2212 by 1672 pixels, 45° FOV:
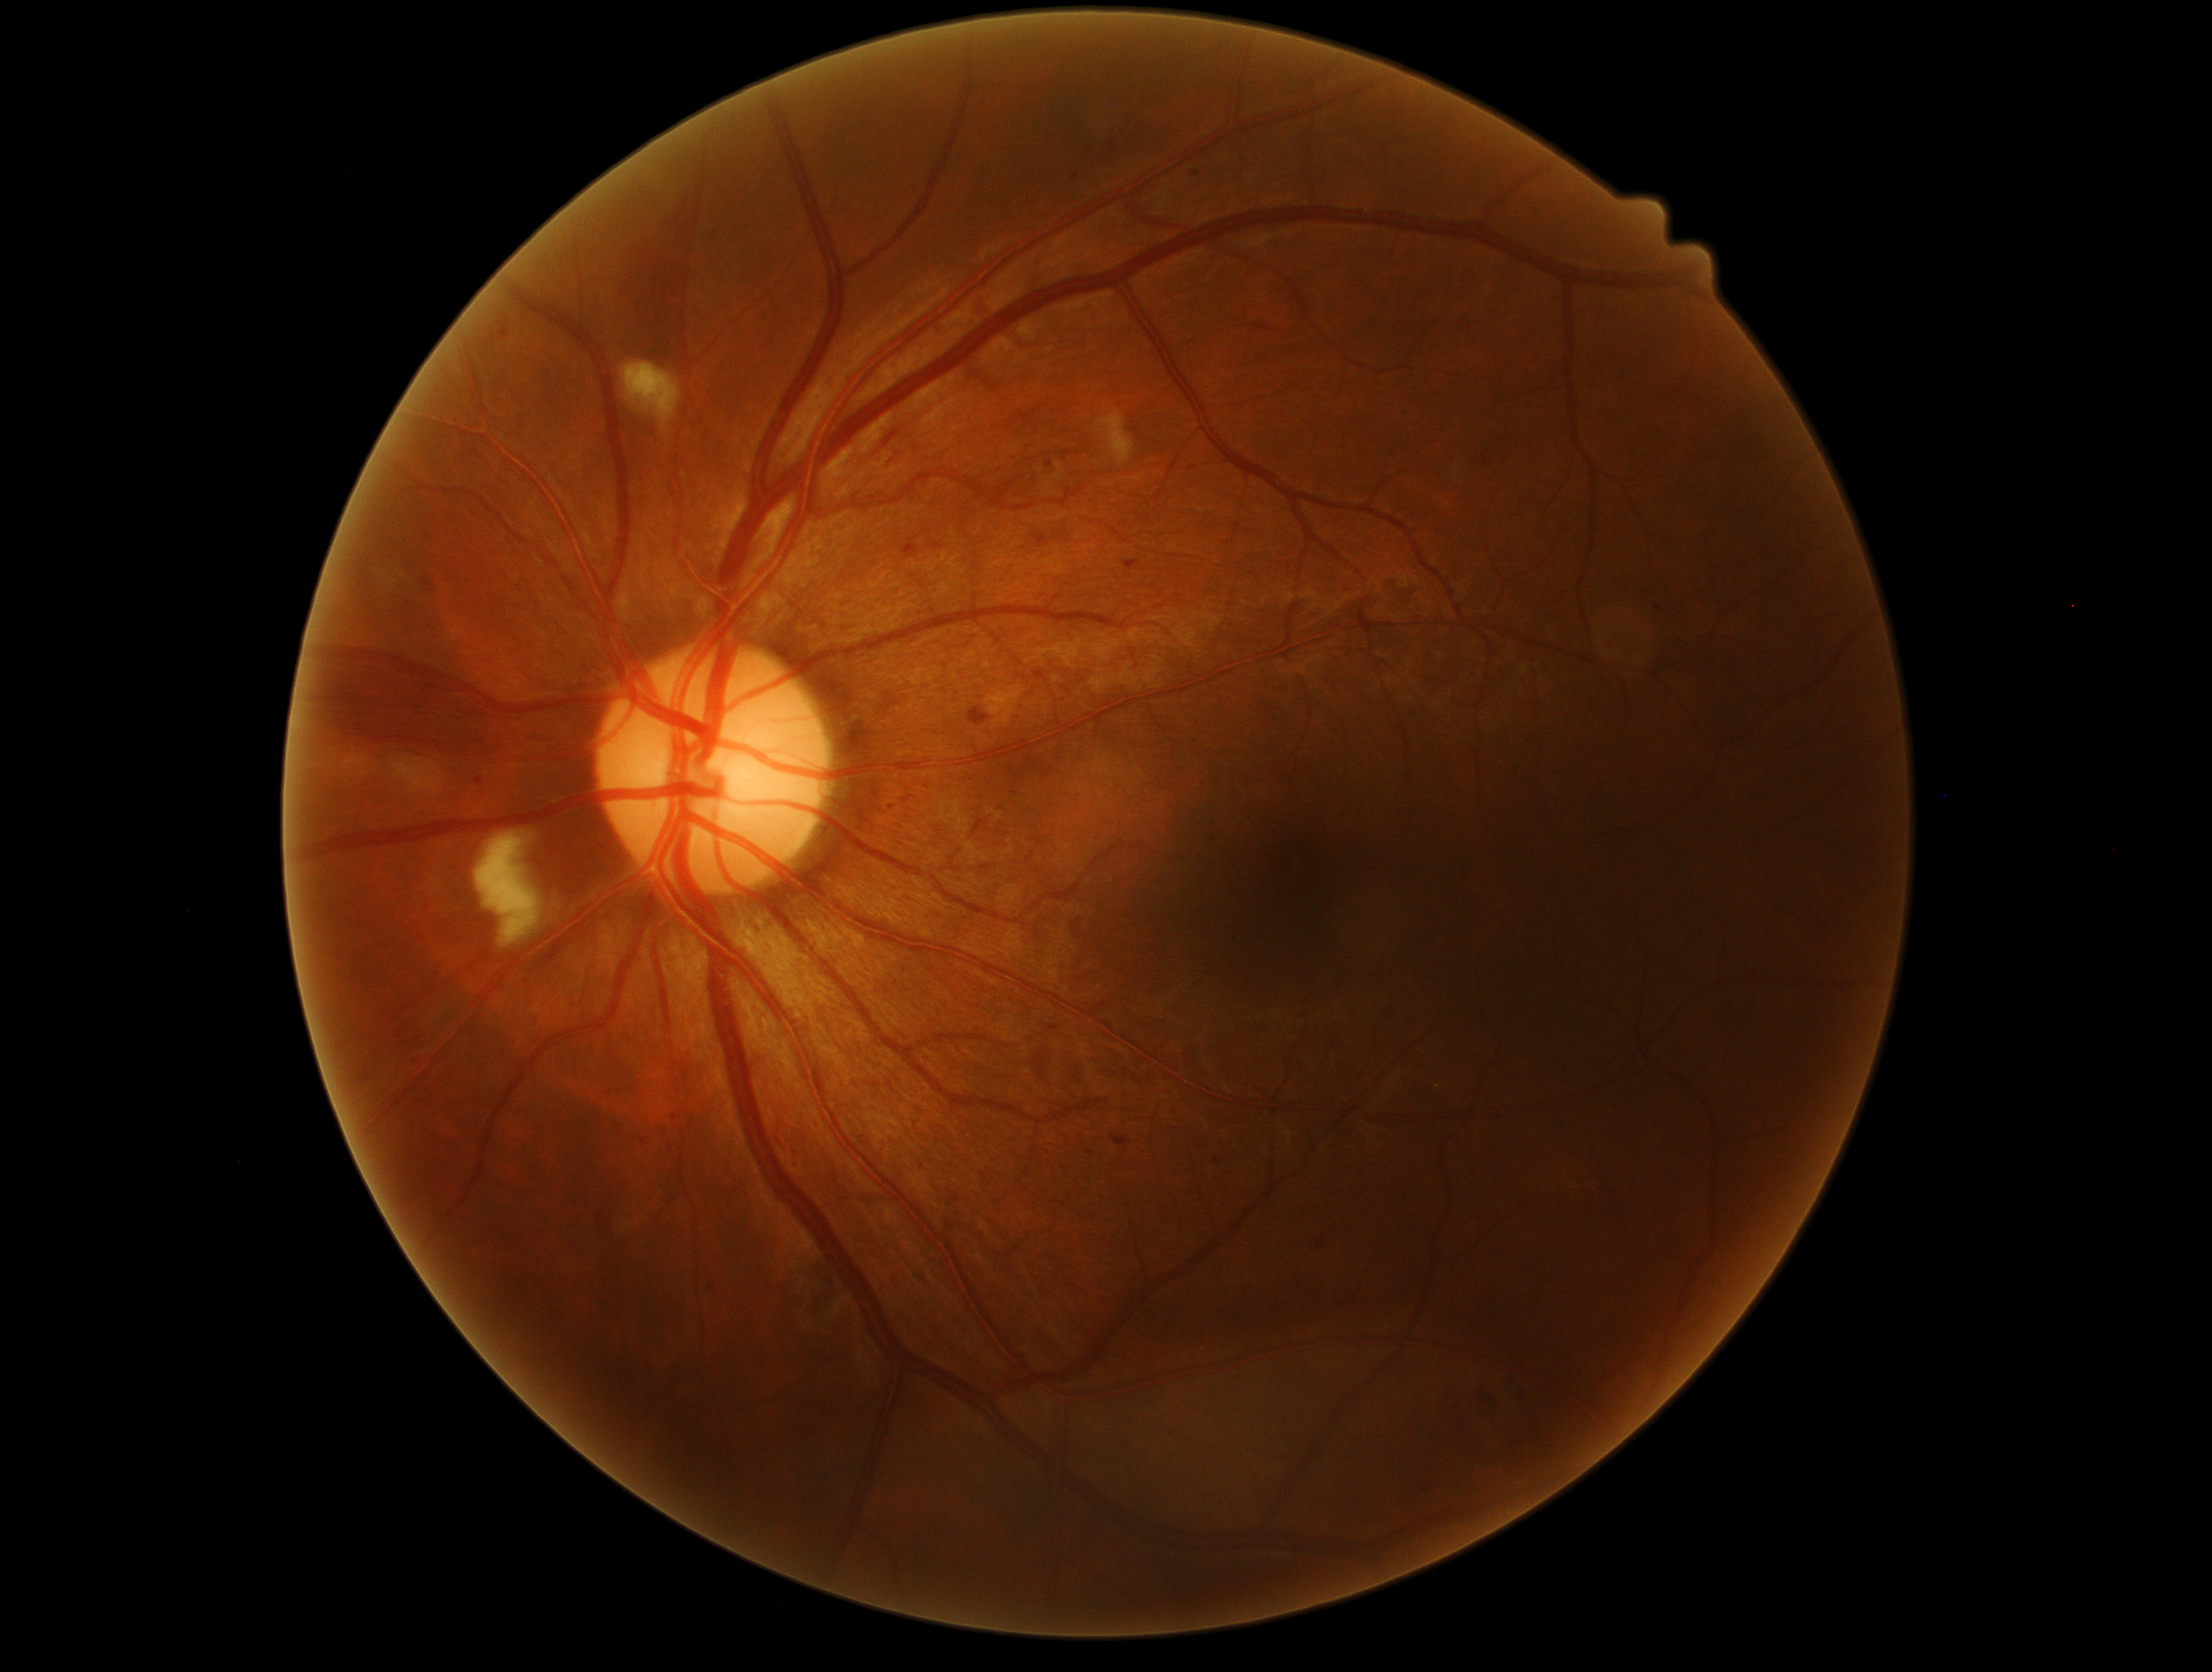 dr_grade: moderate non-proliferative diabetic retinopathy (grade 2) — more than just microaneurysms but less than severe NPDR